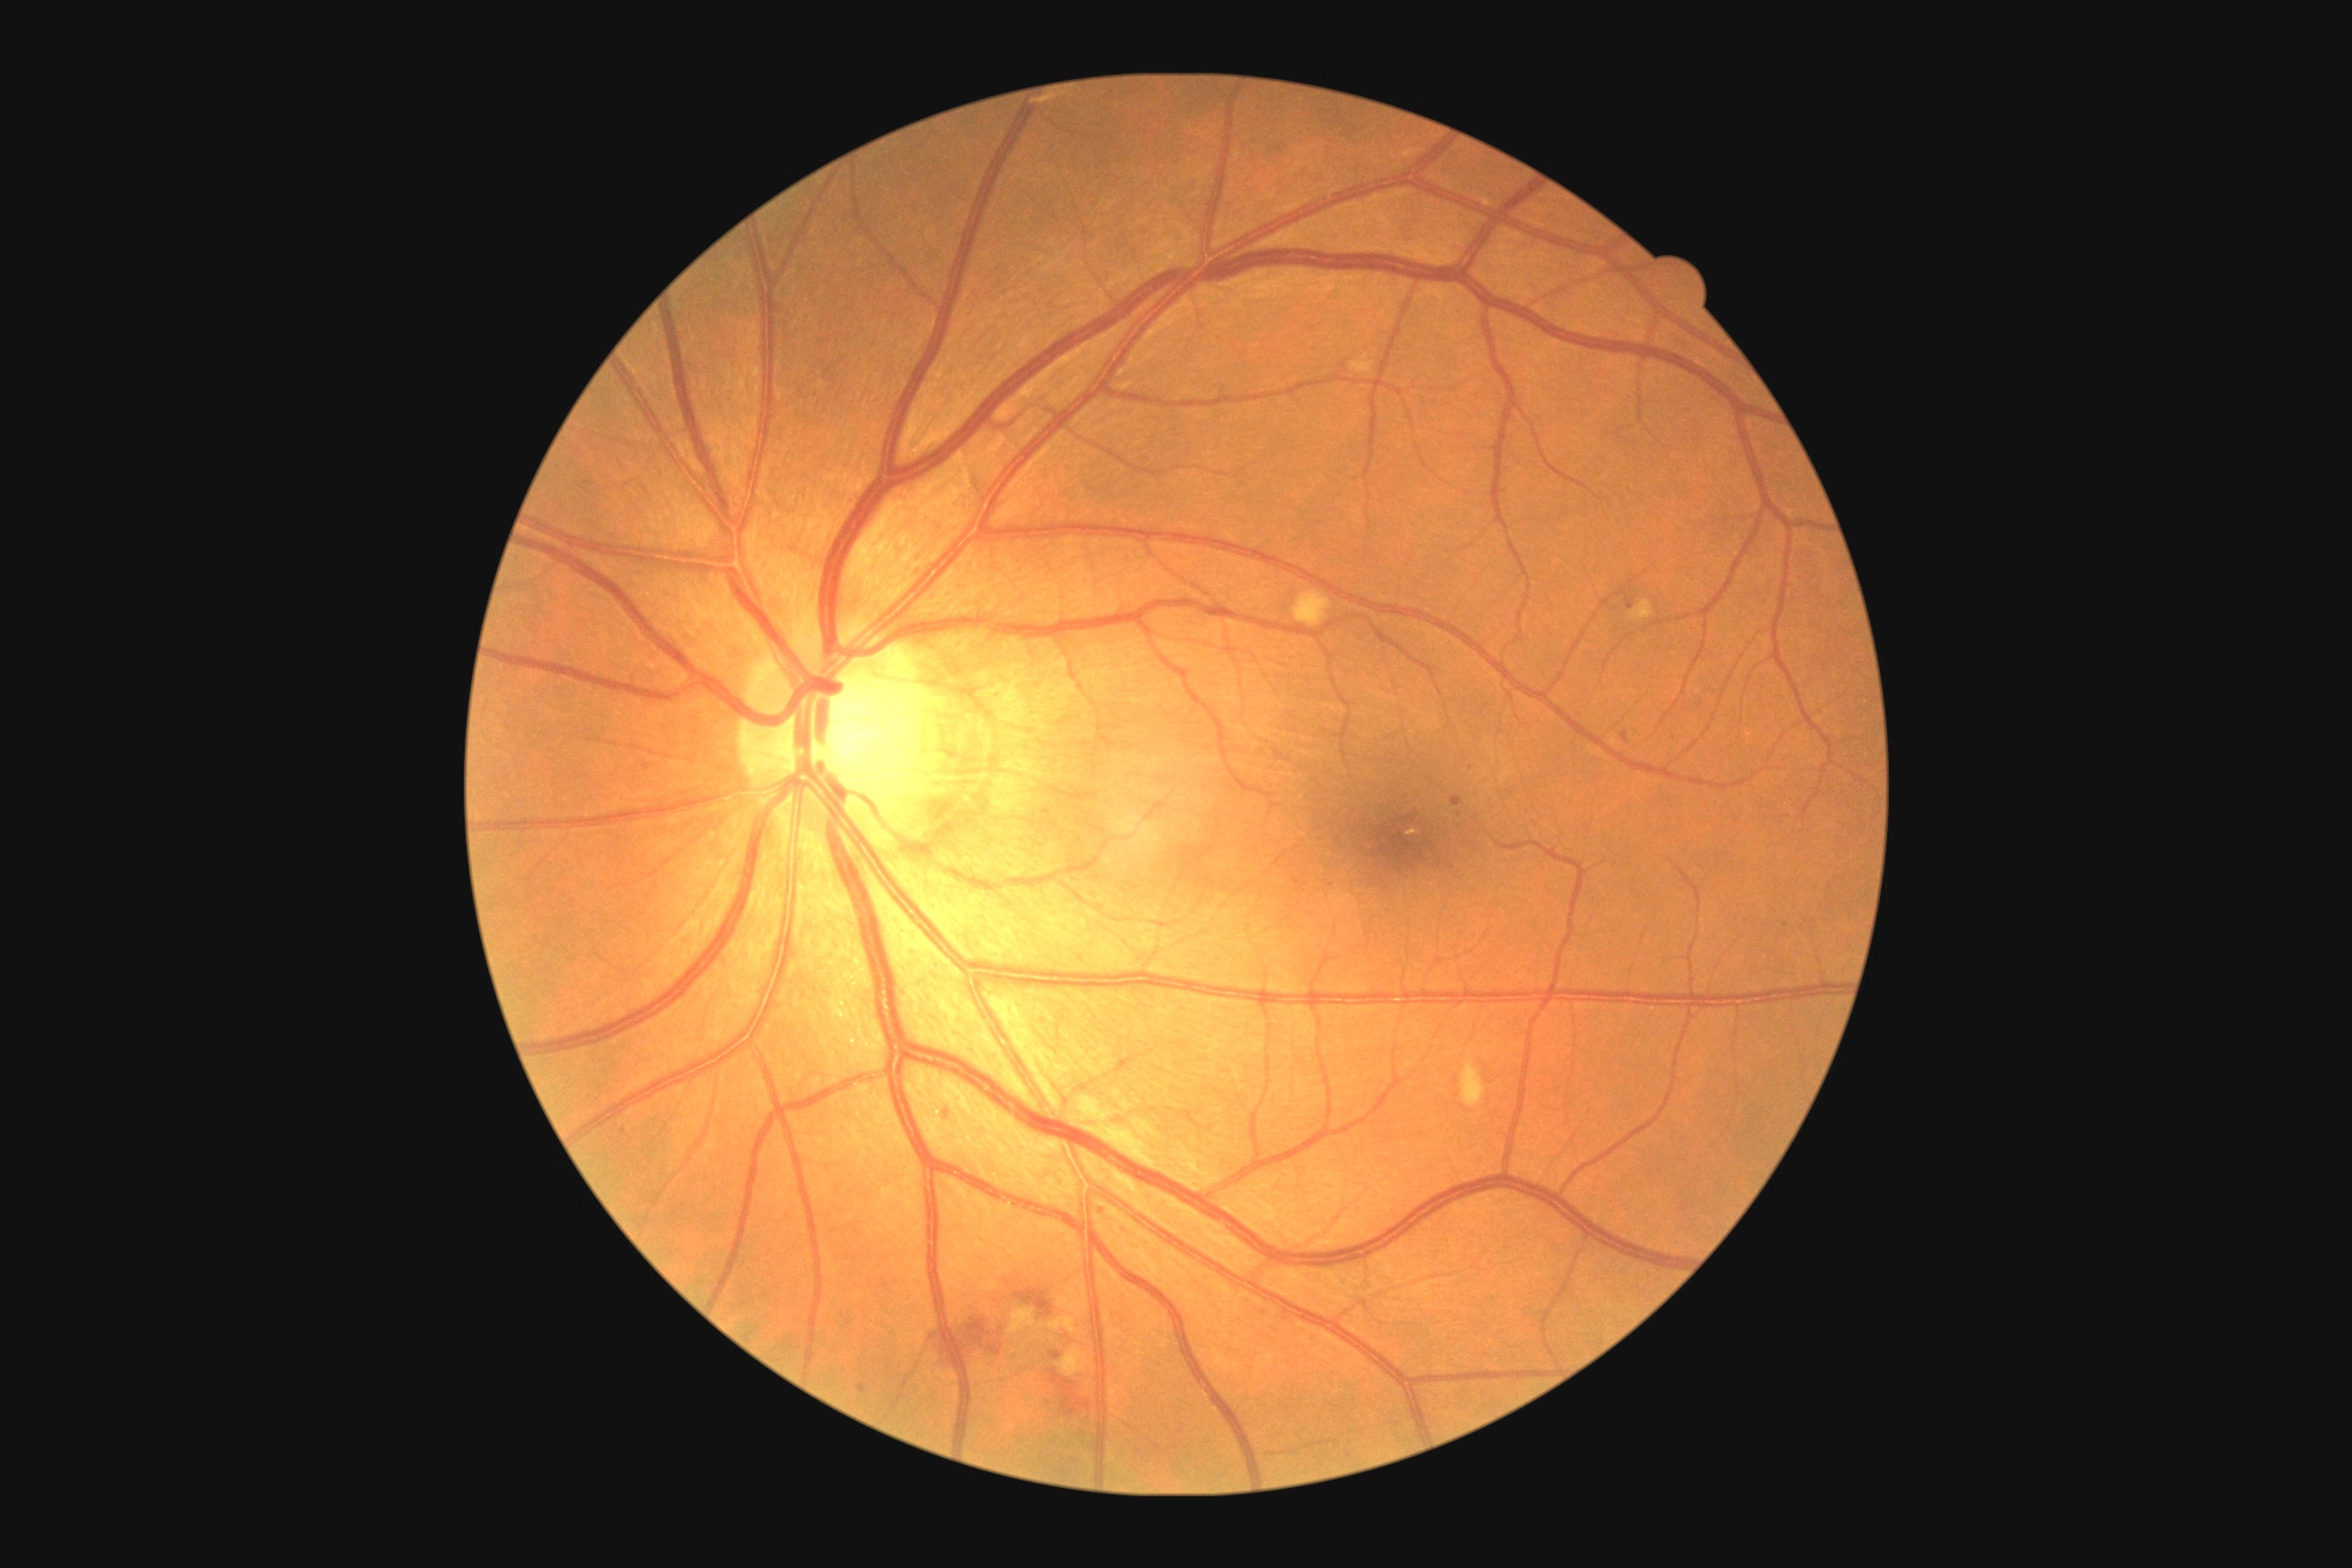
<lesions>
  <dr_grade>2</dr_grade>
  <se><box>1293,593,1333,627</box>, <box>1462,1059,1485,1108</box>, <box>1631,600,1654,623</box>, <box>1008,1308,1037,1335</box>, <box>1050,1317,1077,1335</box>, <box>1059,1348,1090,1377</box></se>
  <ex />
  <he><box>945,1318,1001,1366</box>, <box>1015,1289,1054,1317</box>, <box>1046,1369,1093,1415</box></he>
  <ma><box>1622,732,1629,743</box>, <box>859,1384,867,1395</box>, <box>1627,600,1634,609</box>, <box>1052,1353,1063,1360</box>, <box>1453,796,1464,807</box></ma>
  <ma_small_centers>[1102,1211], [1460,815], [1535,825], [1786,925], [946,1114], [624,1132]</ma_small_centers>
</lesions>